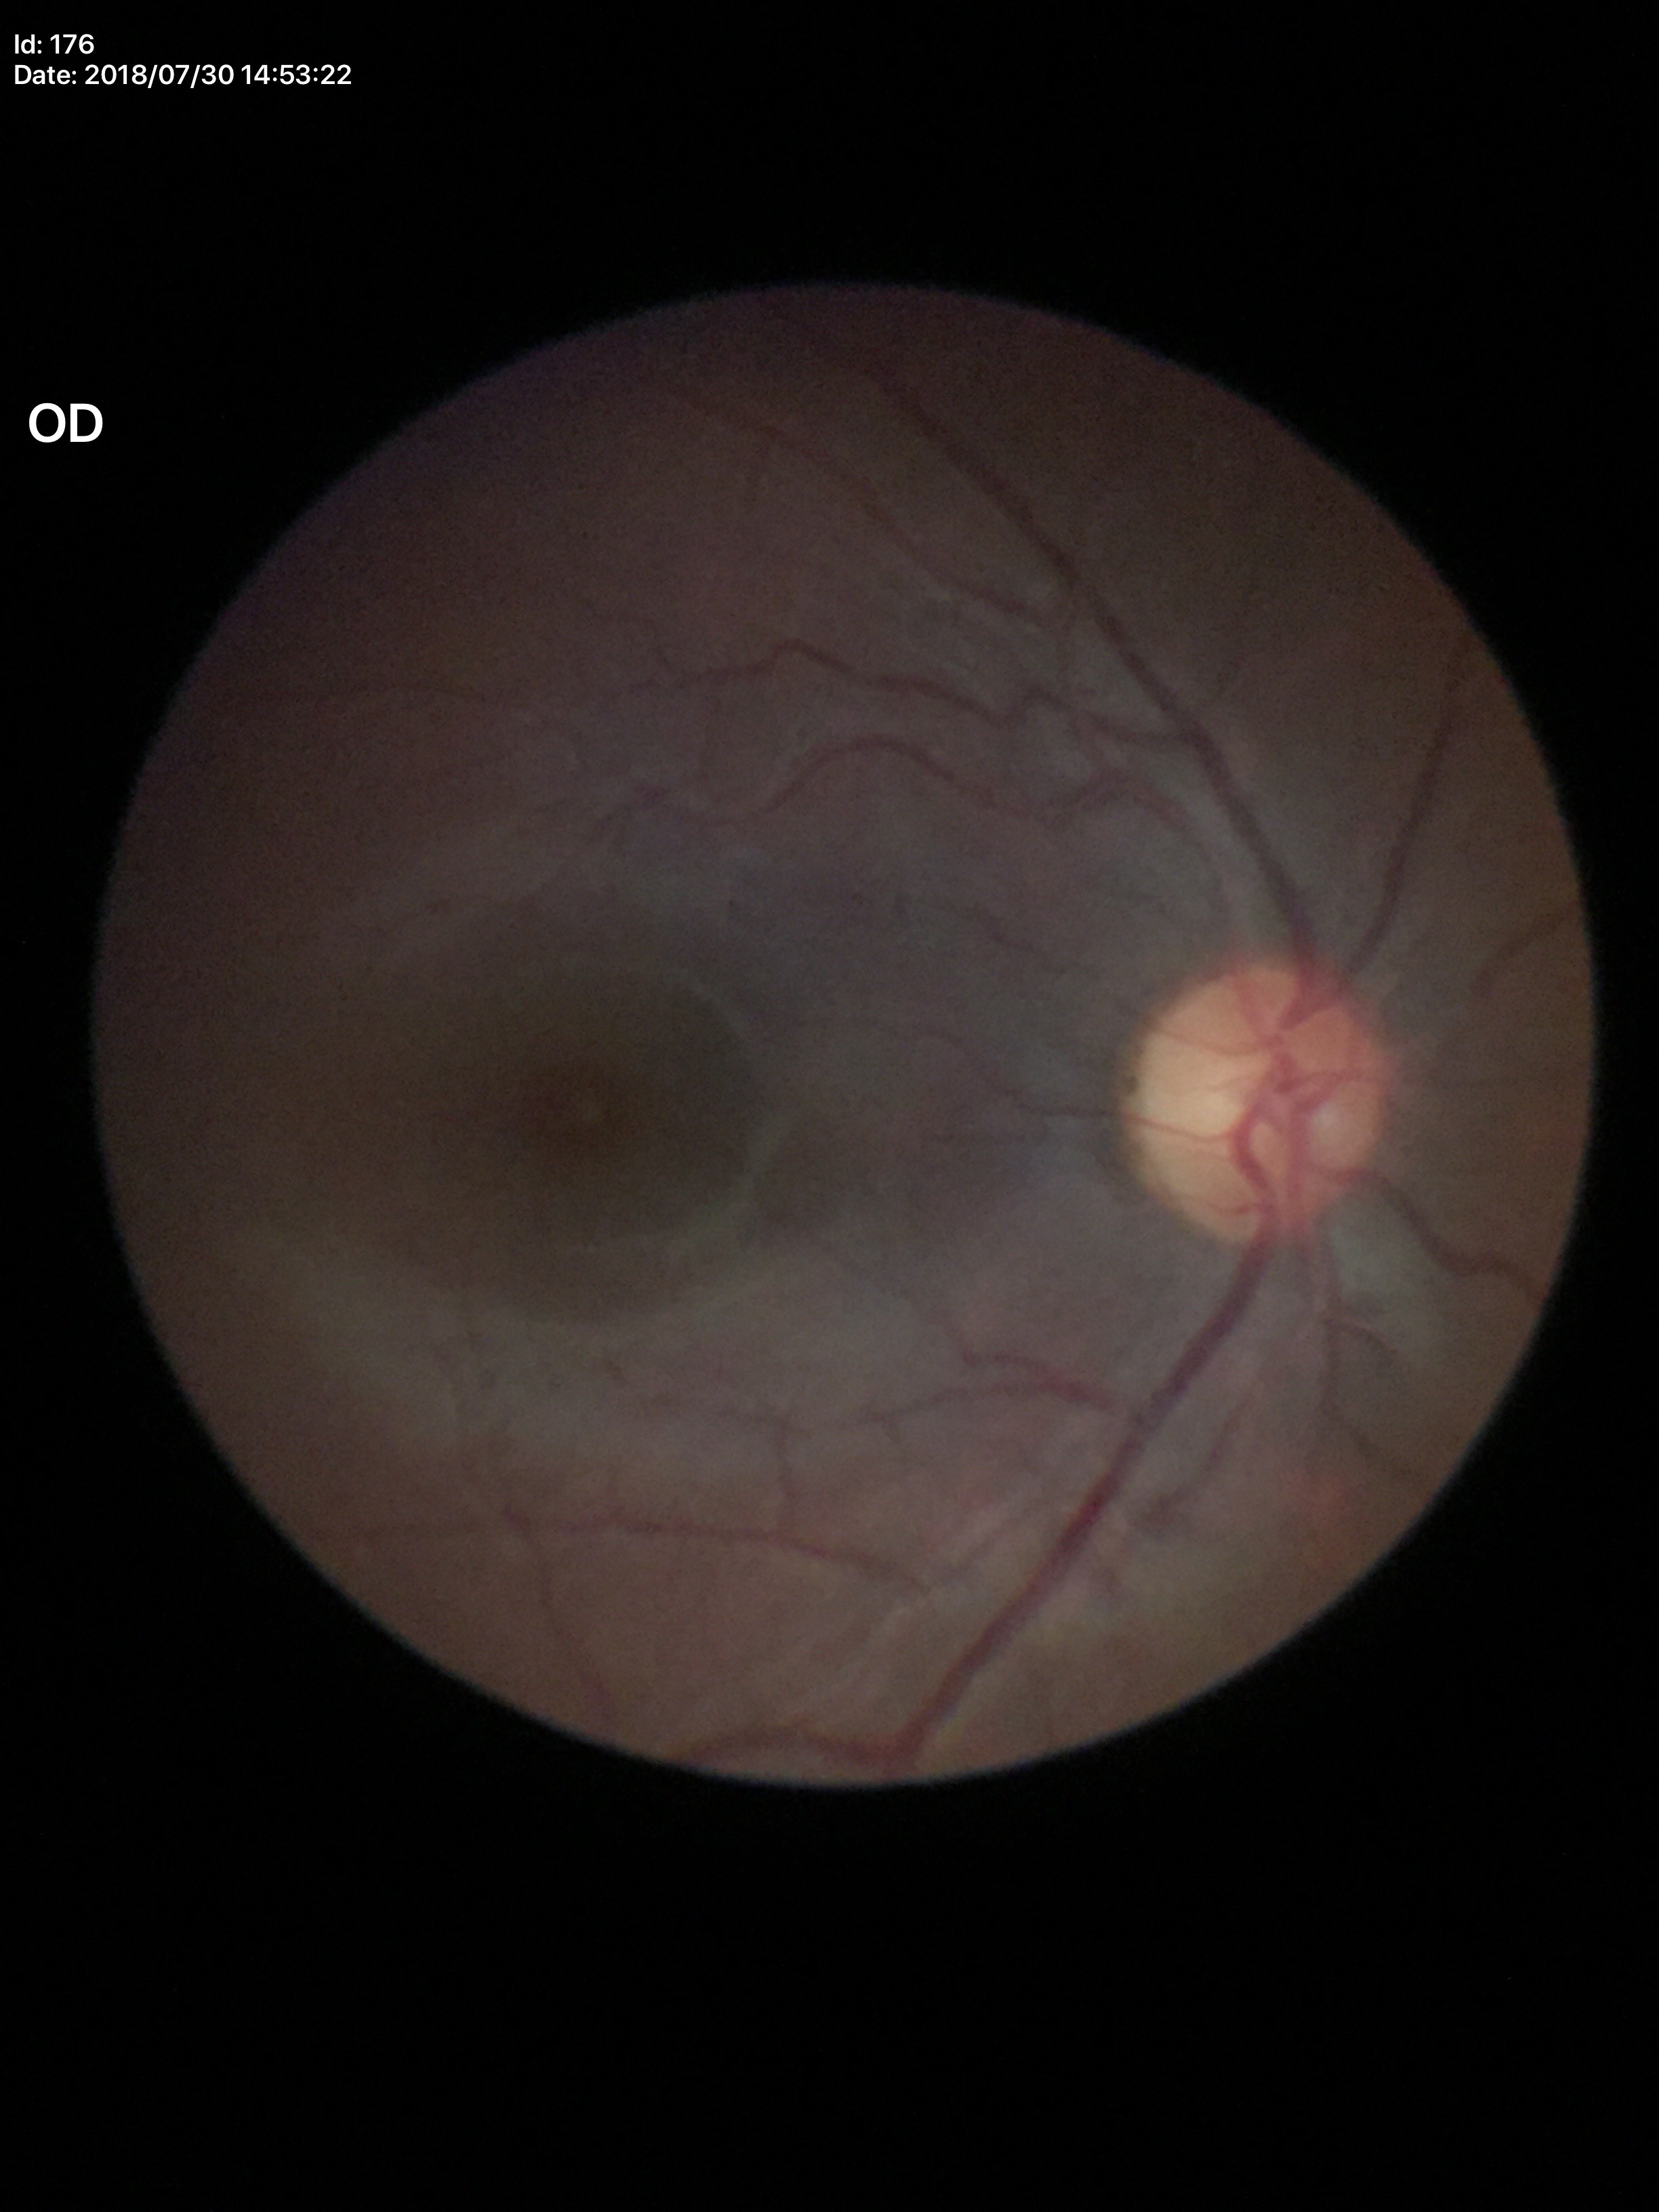
Vertical CDR: 0.48.
Negative for glaucoma suspicion.
Horizontal CDR of 0.47.